Wide-field contact fundus photograph of an infant · Phoenix ICON, 100° FOV: 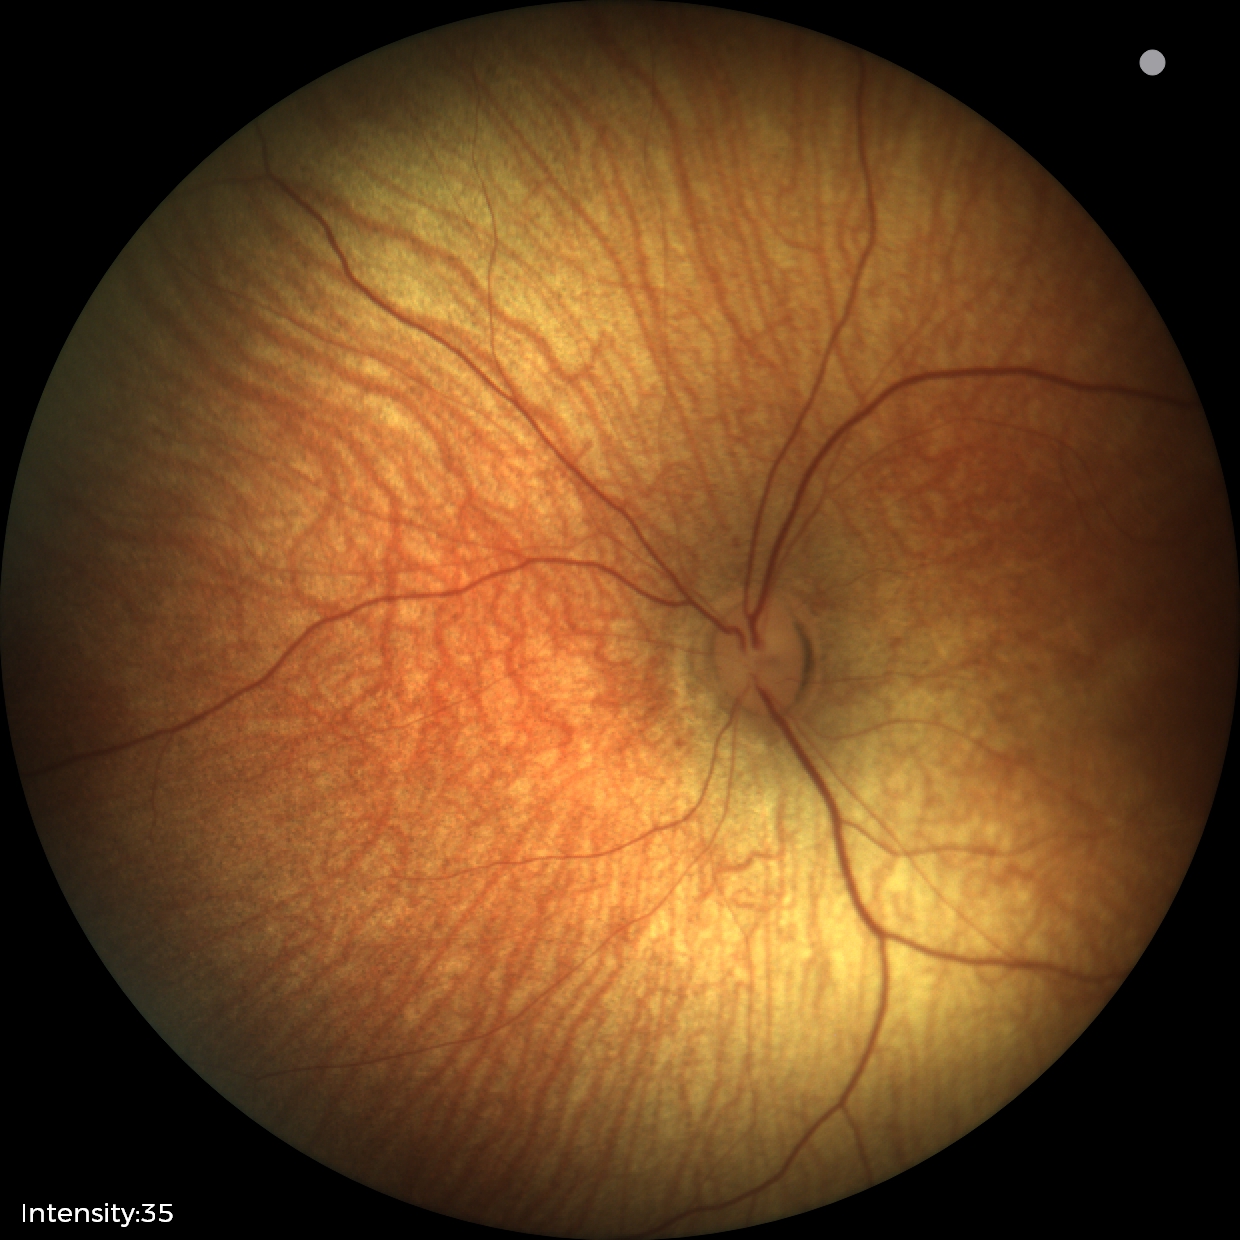 No retinal pathology identified on screening.